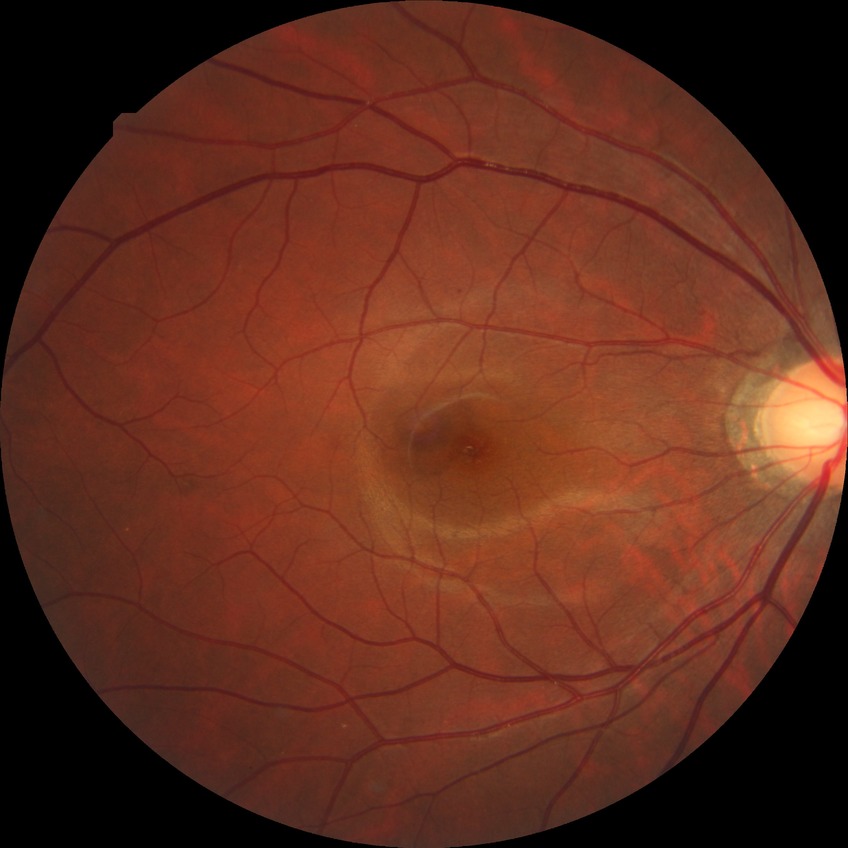 Annotations:
* diabetic retinopathy (DR) — simple diabetic retinopathy (SDR)